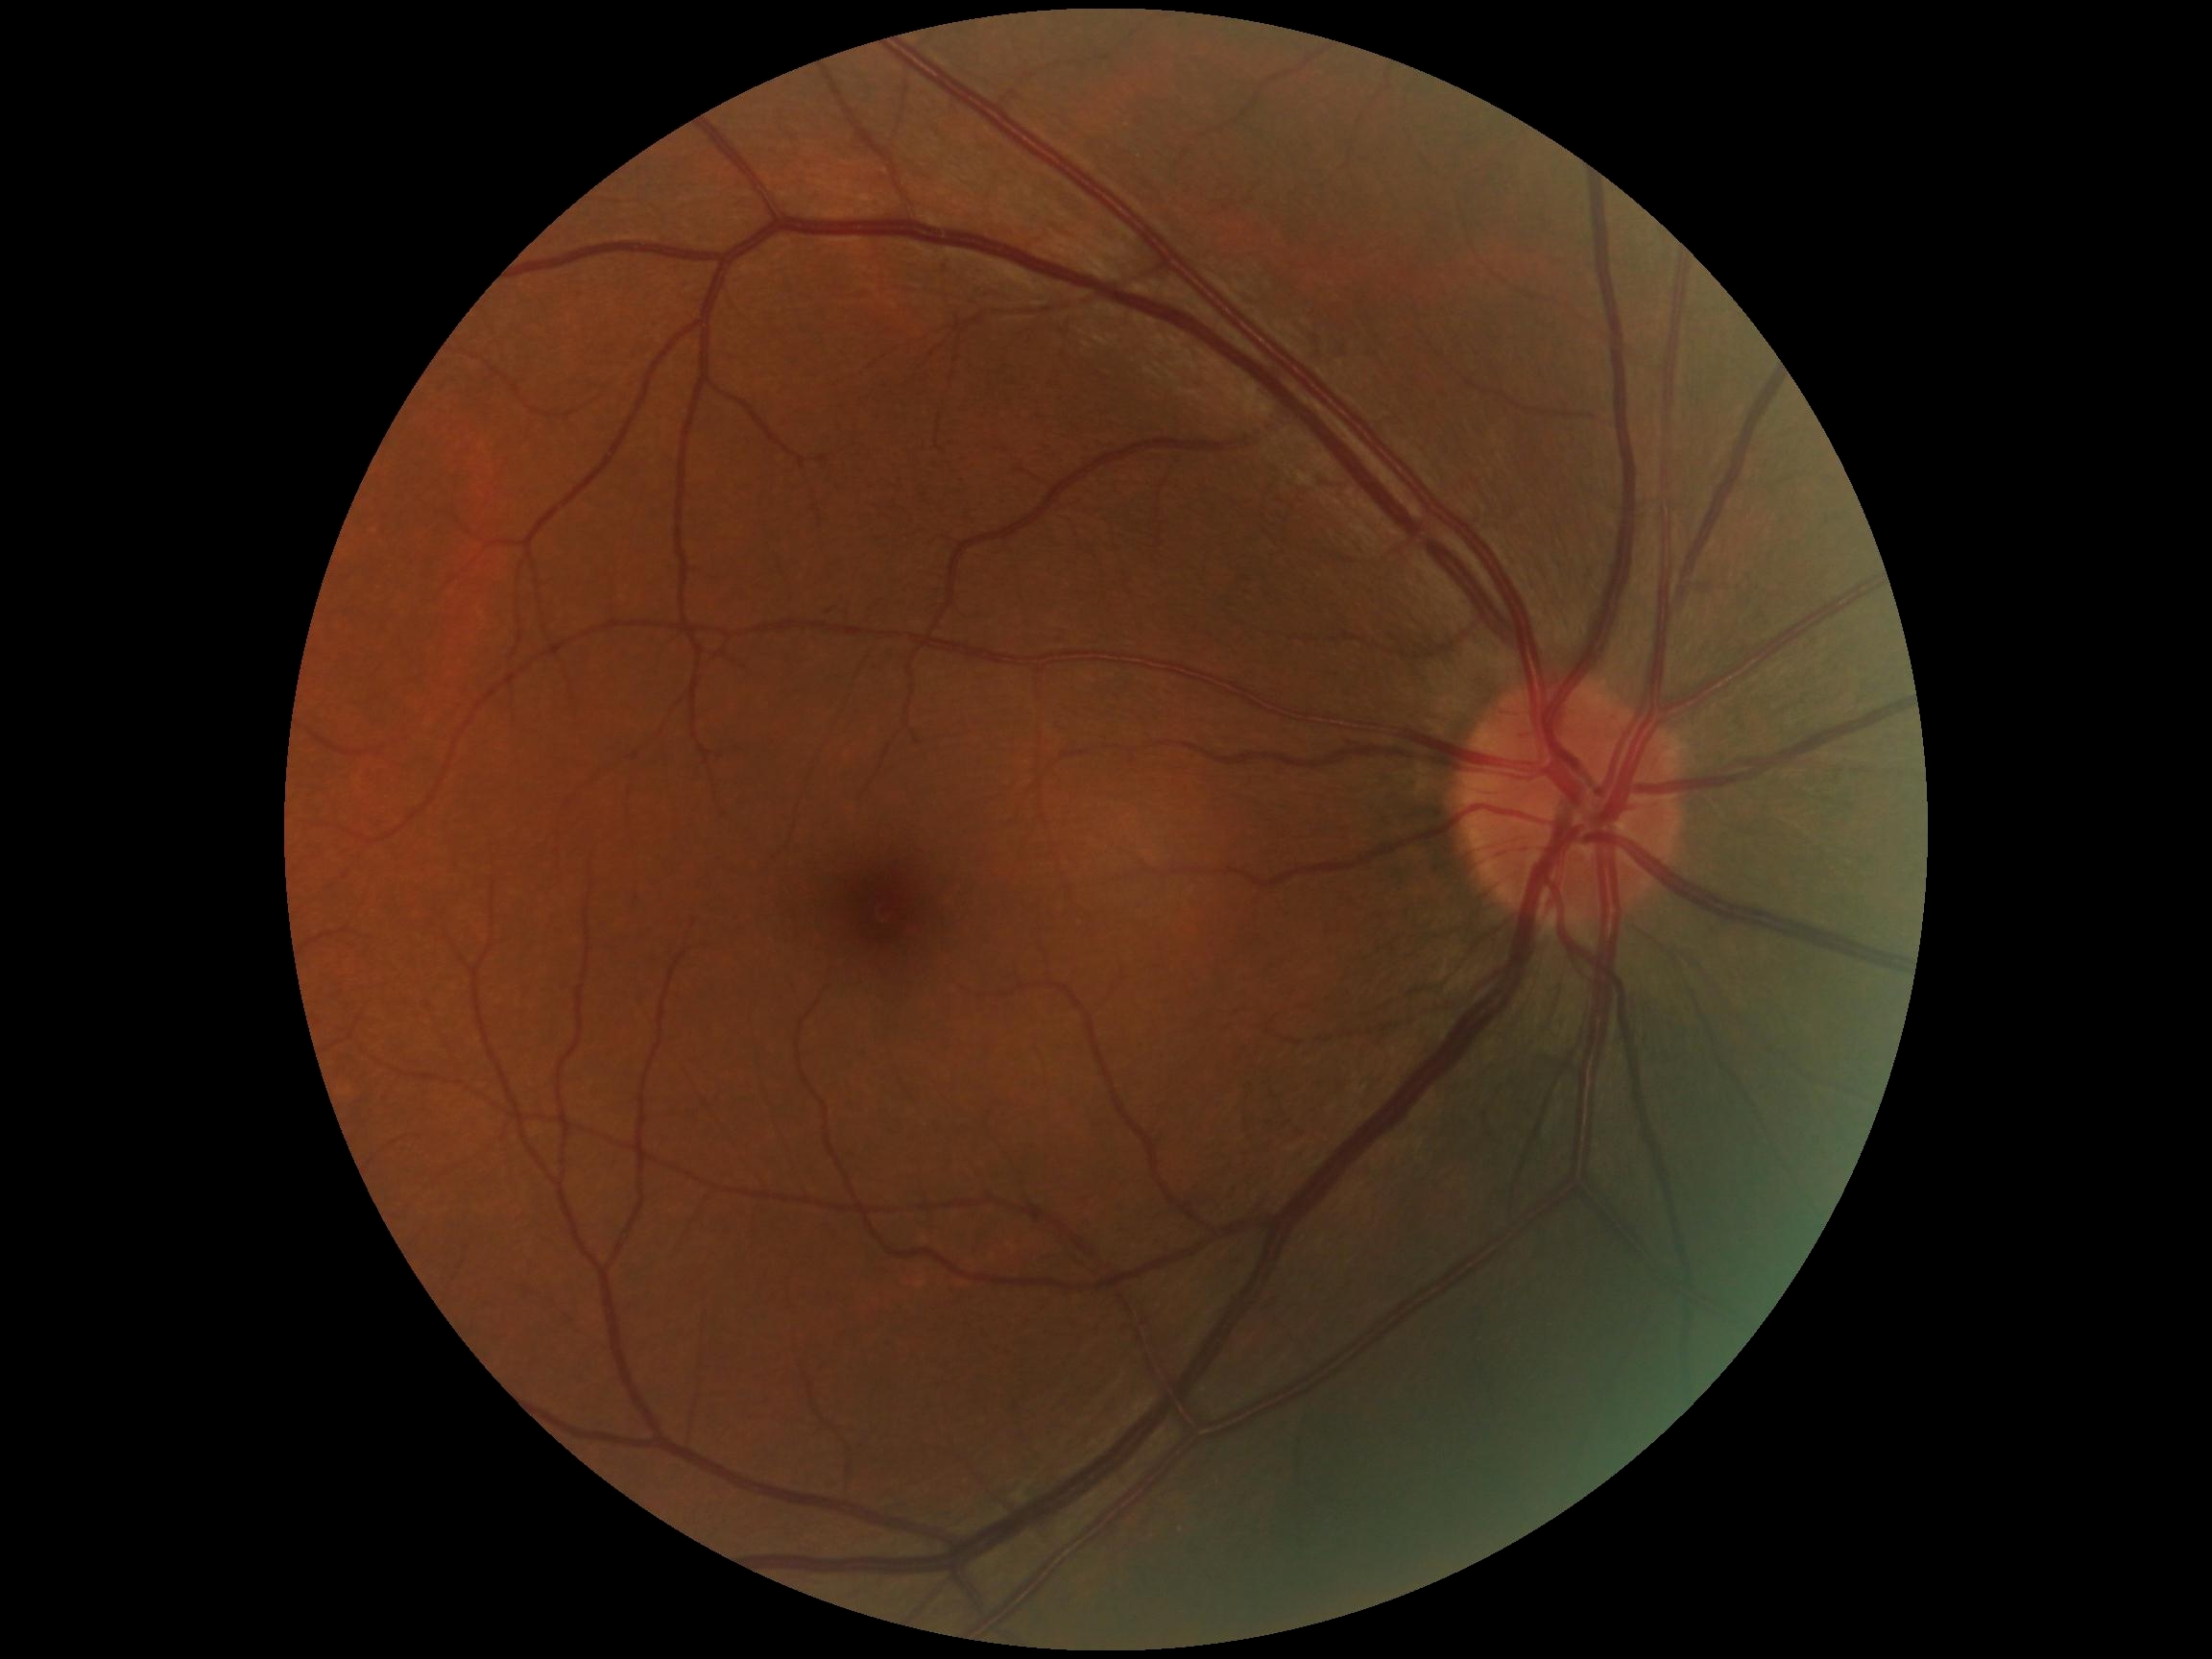

Diabetic retinopathy grade is 0 (no apparent retinopathy).